Nonmydriatic fundus photograph, acquired with a NIDEK AFC-230
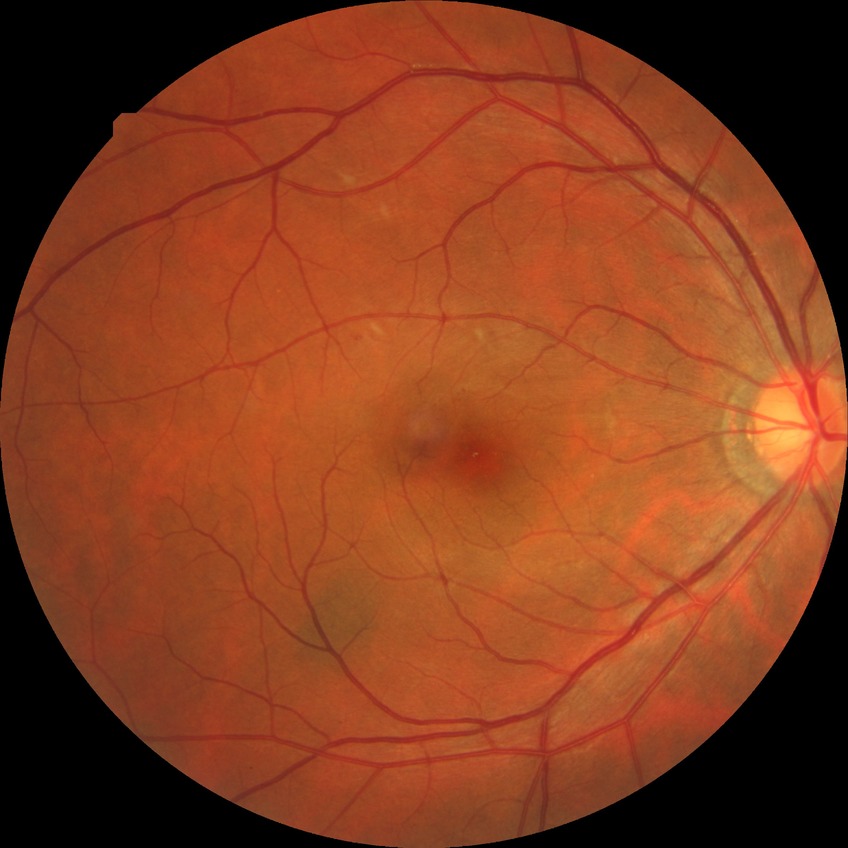
Modified Davis classification is simple diabetic retinopathy.